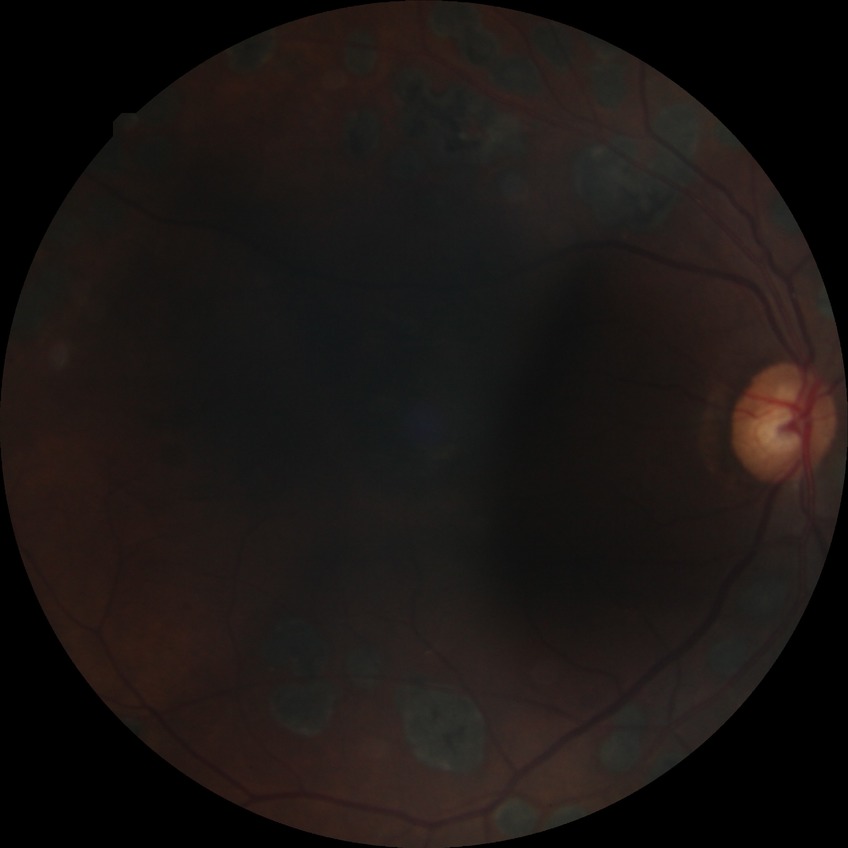

  davis_grade: proliferative diabetic retinopathy